Modified Davis classification.
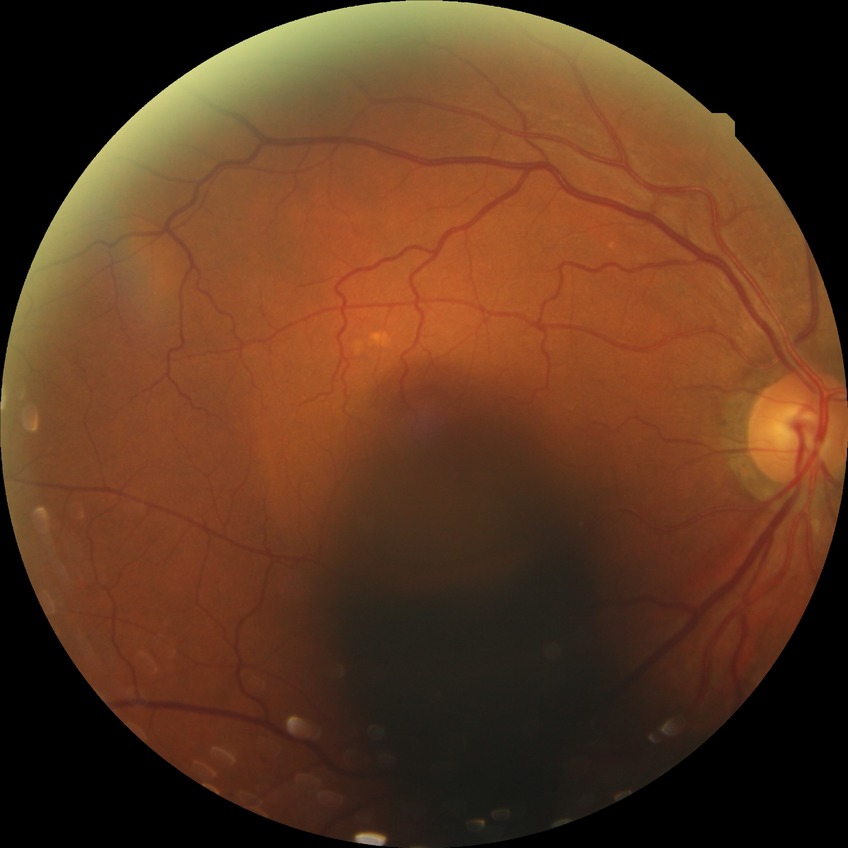

Diabetic retinopathy grade: no diabetic retinopathy.